Captured on a Nidek AFC-330 fundus camera. Non-mydriatic fundus camera
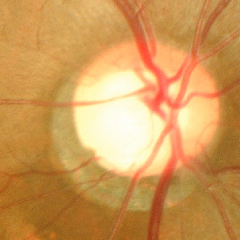

Q: Does this eye have glaucoma?
A: Yes — advanced glaucoma.